Color fundus image
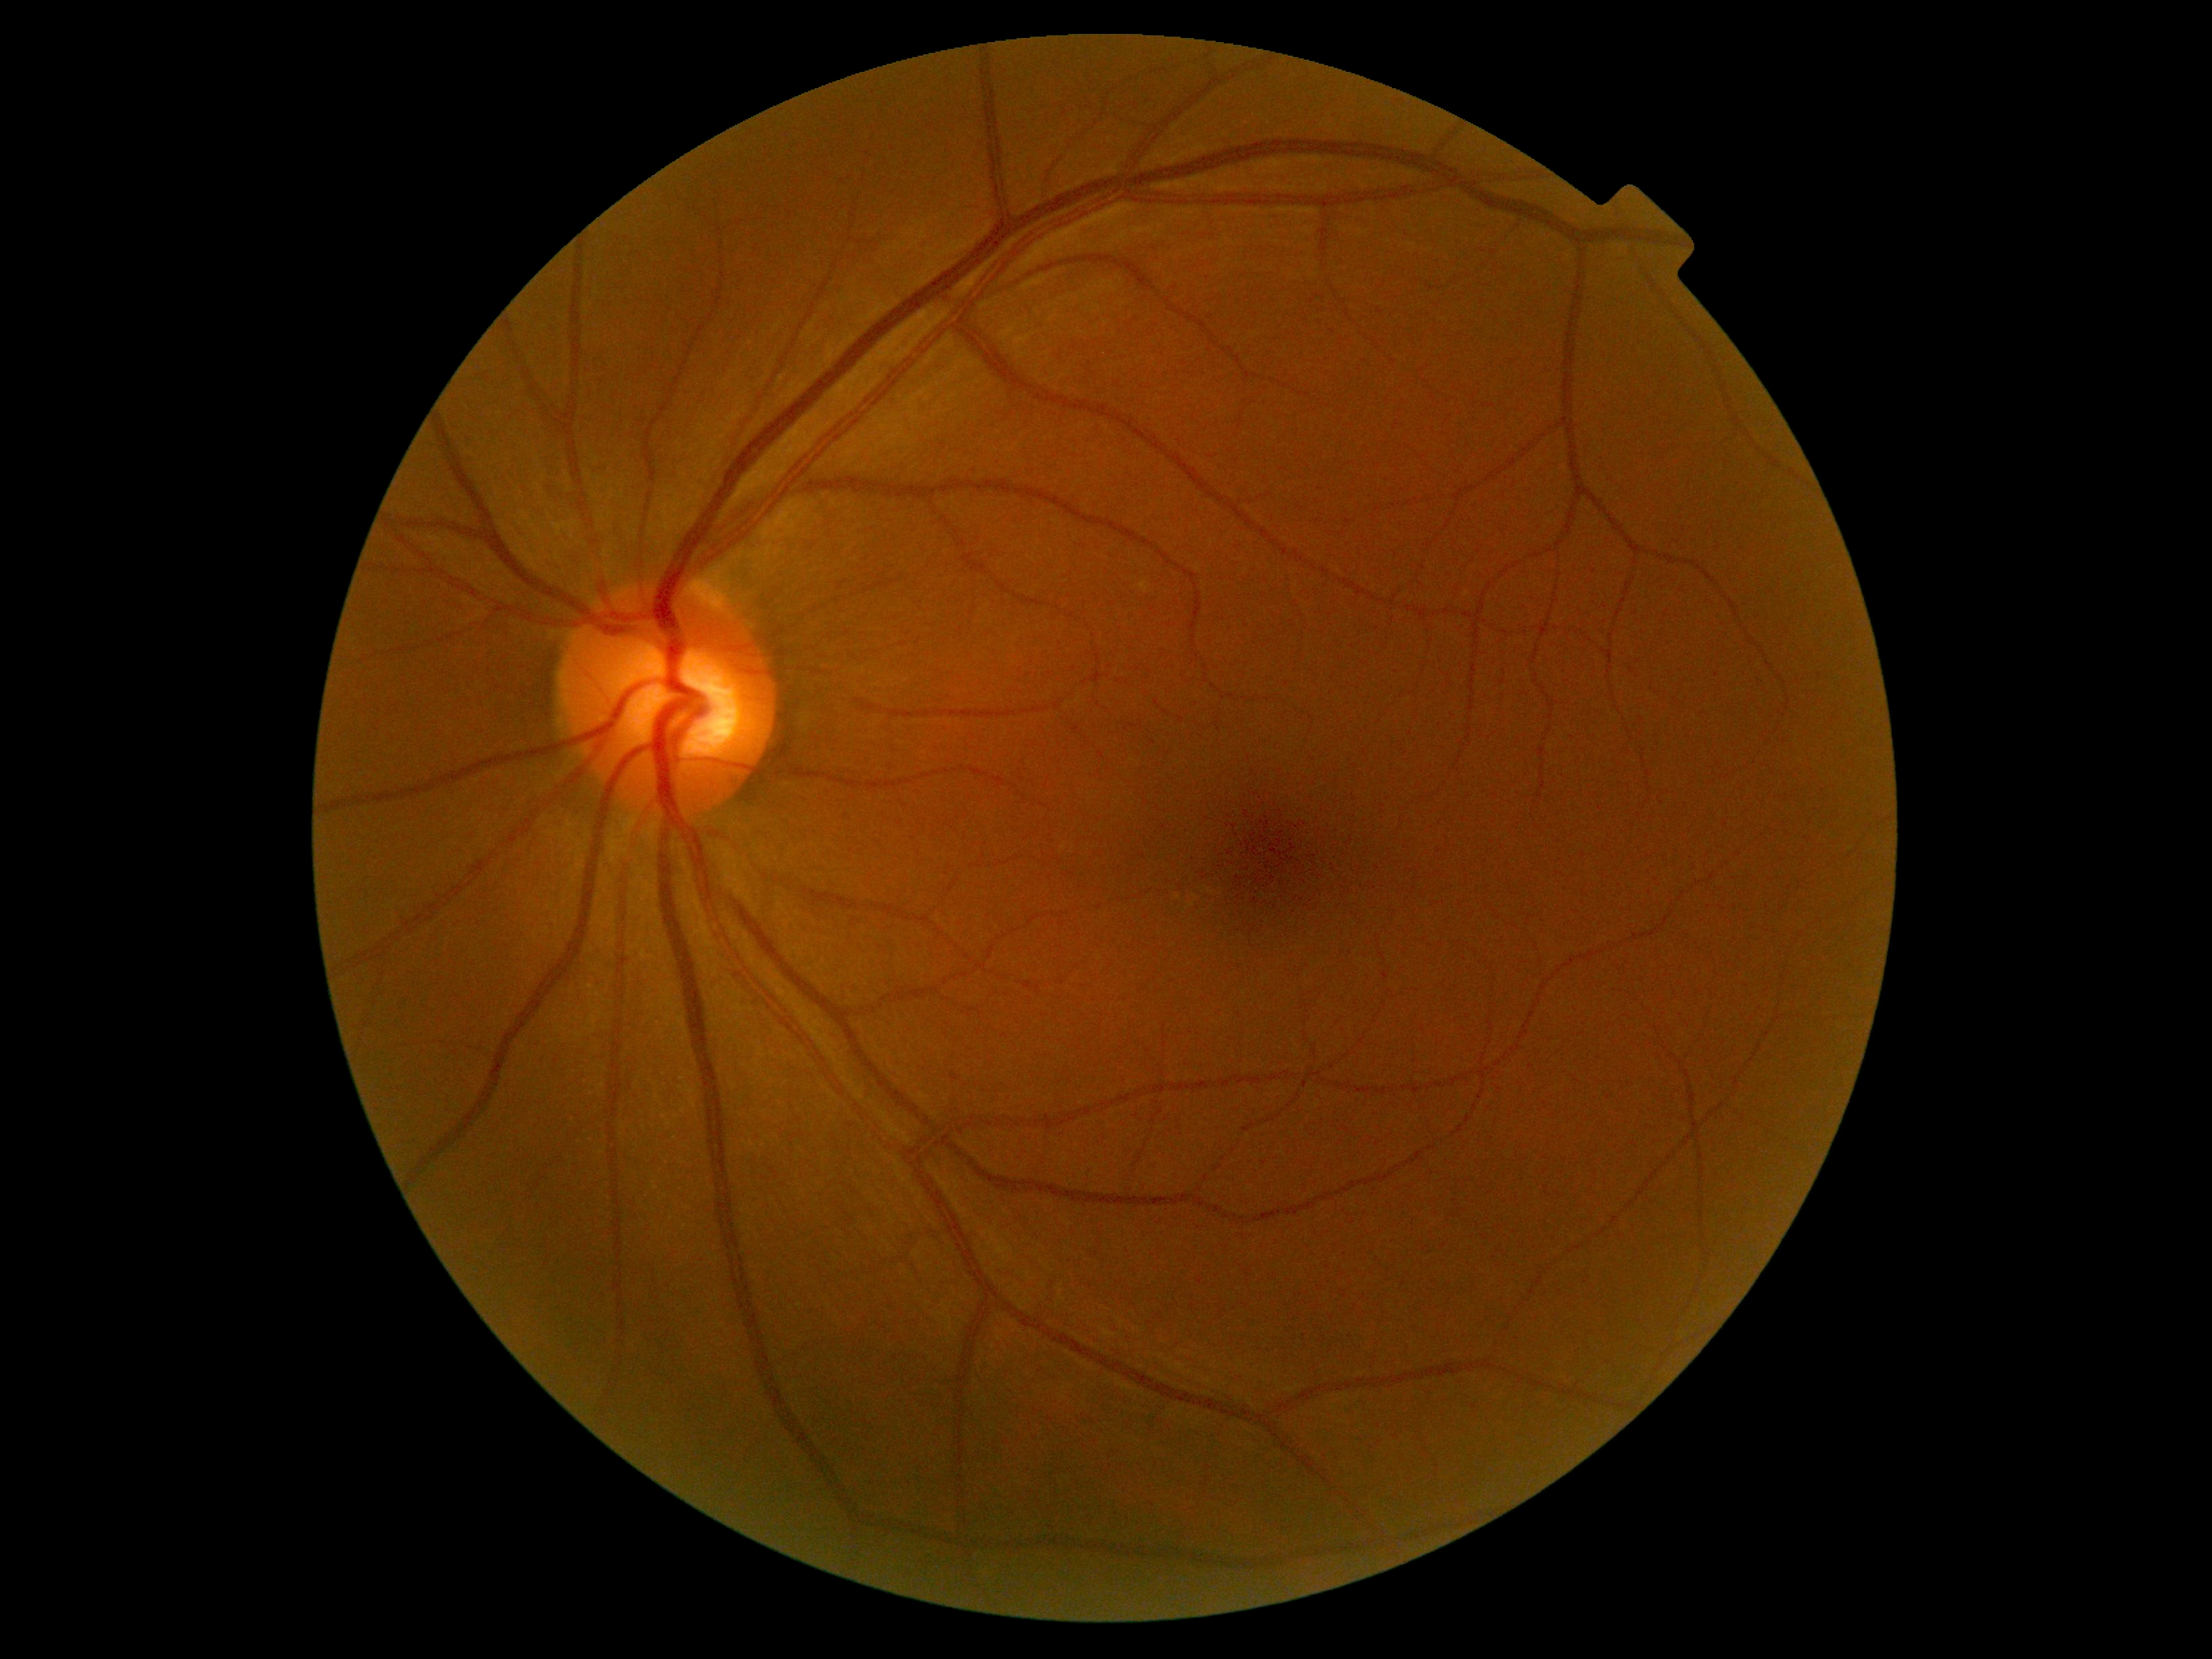
- DR severity — grade 0